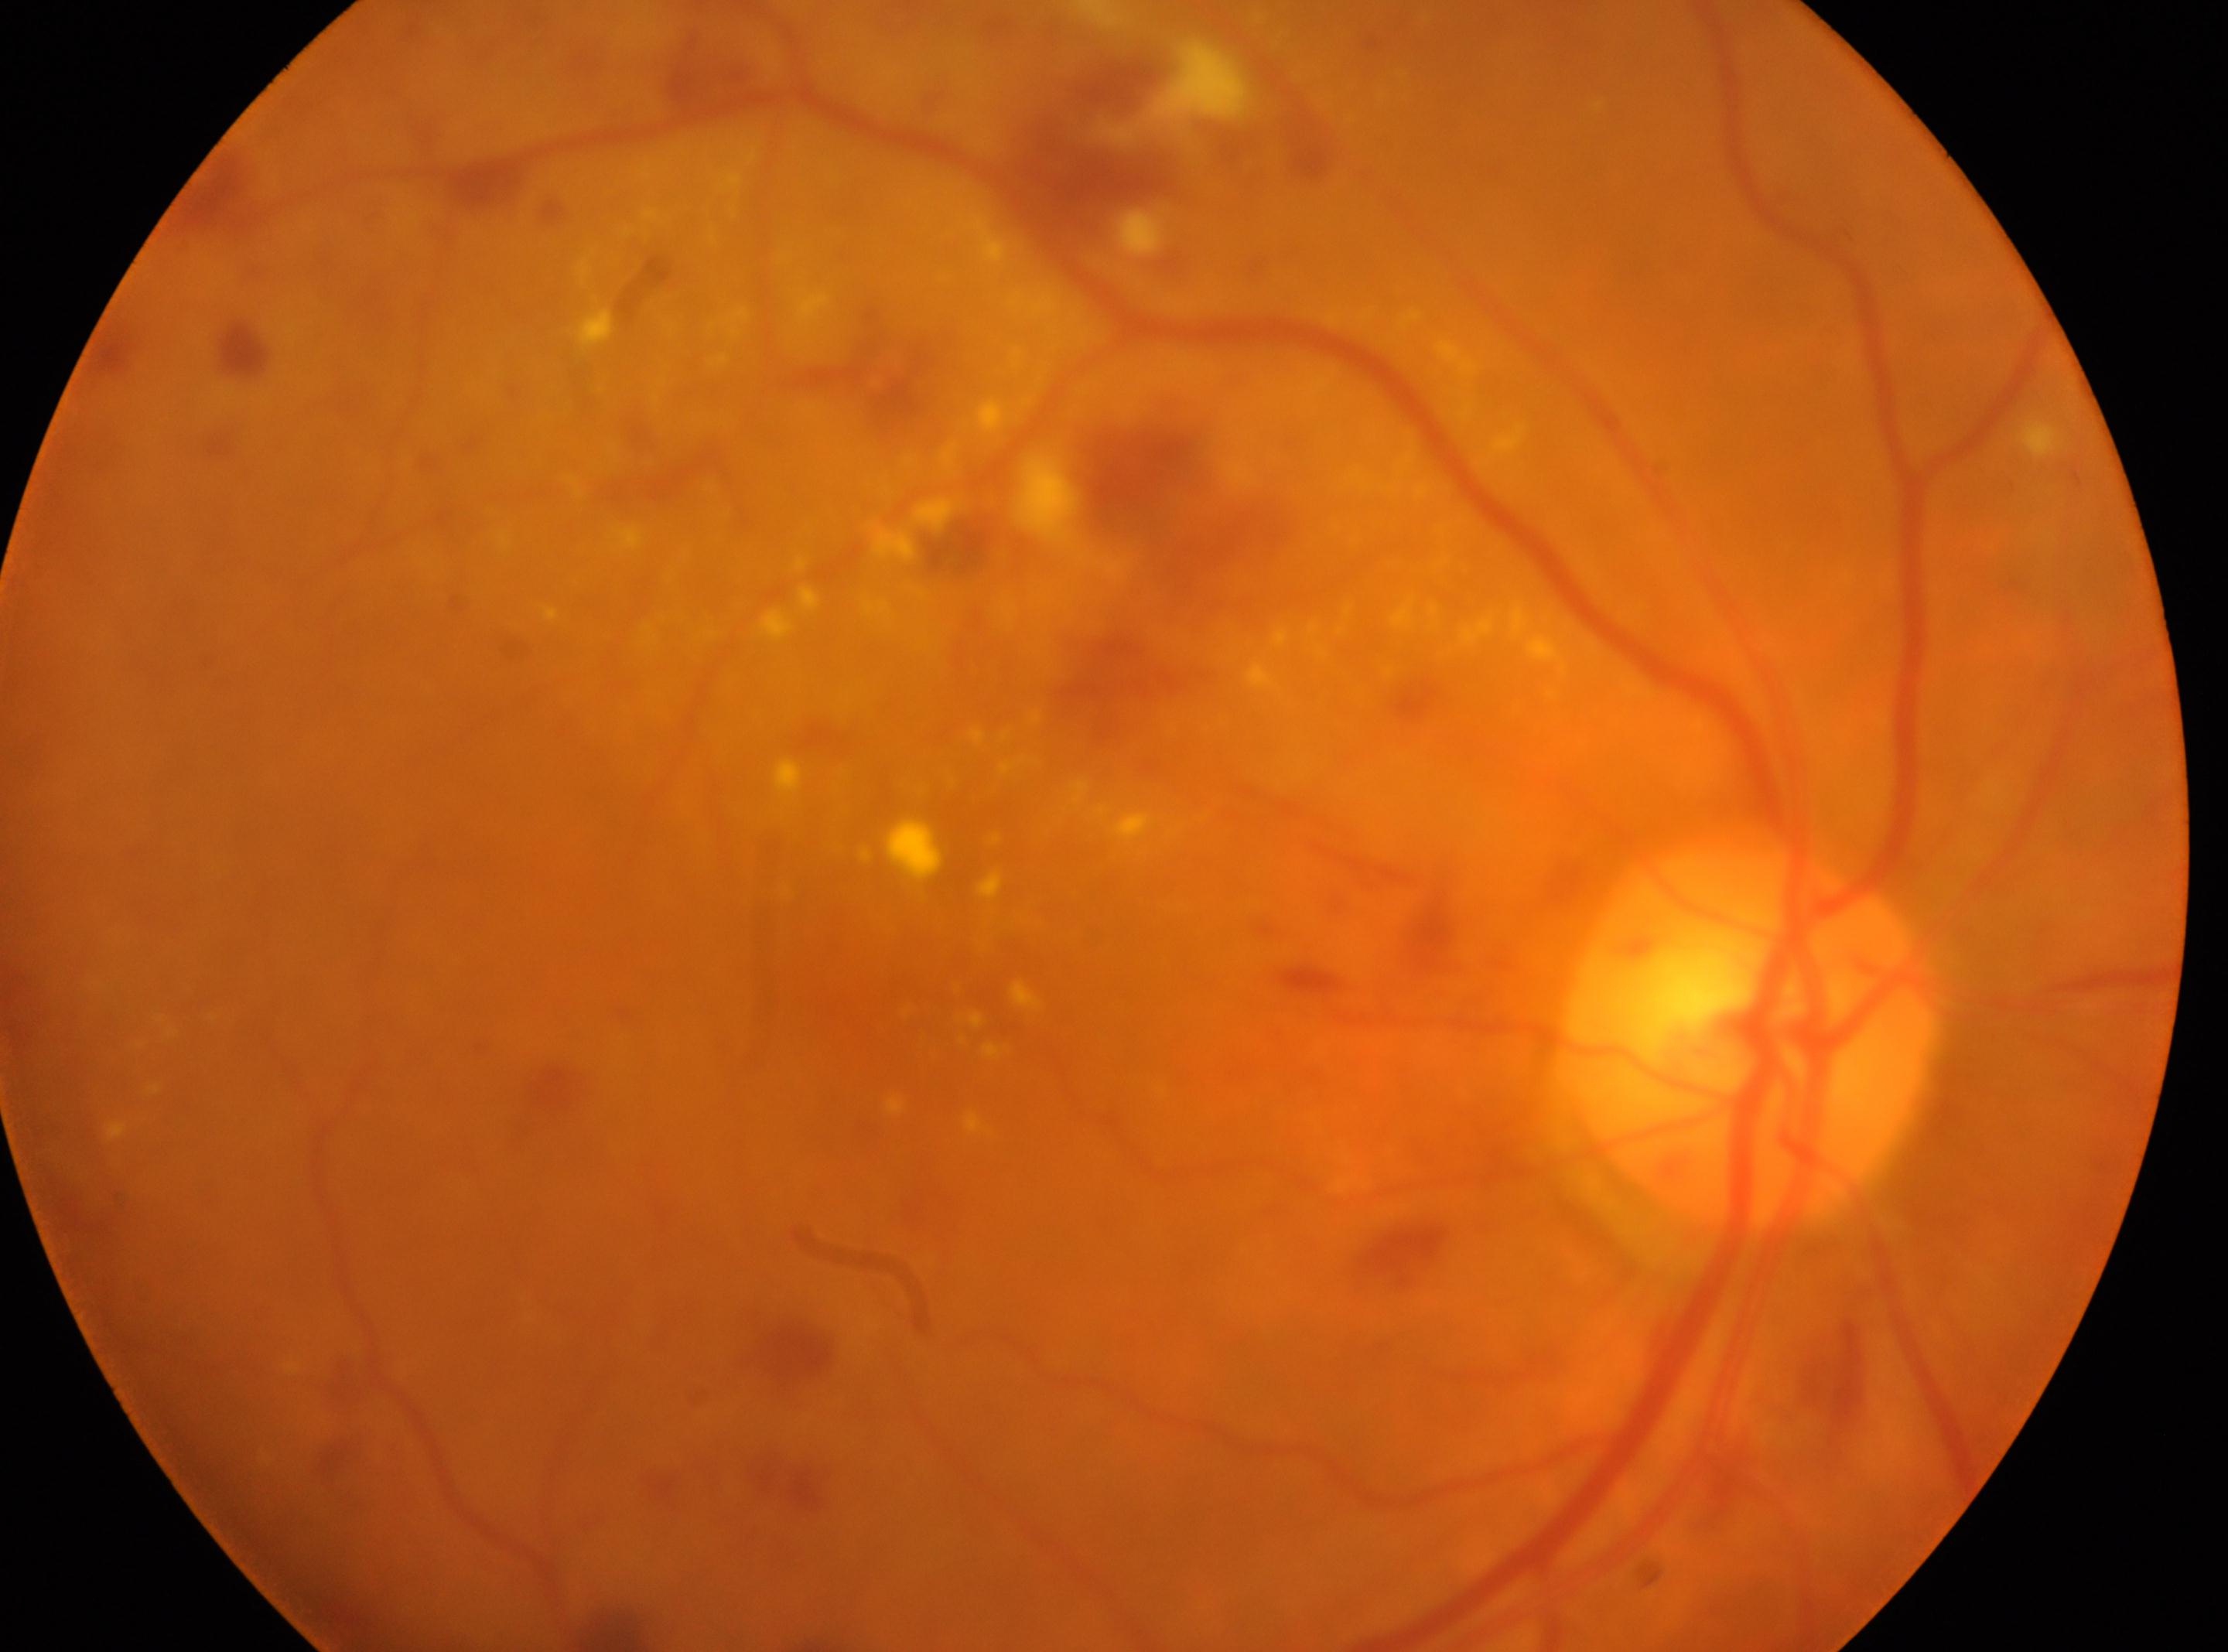
{
  "eye": "OD",
  "optic_disc": "(1748, 1035)",
  "fovea": "(899, 998)",
  "dr_grade": "3"
}